240x240px. Camera: Nidek AFC-330
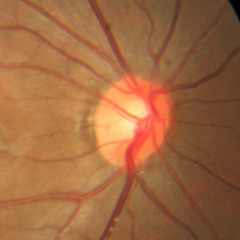

Glaucoma stage = no evidence of glaucoma.